No pharmacologic dilation. Retinal fundus photograph
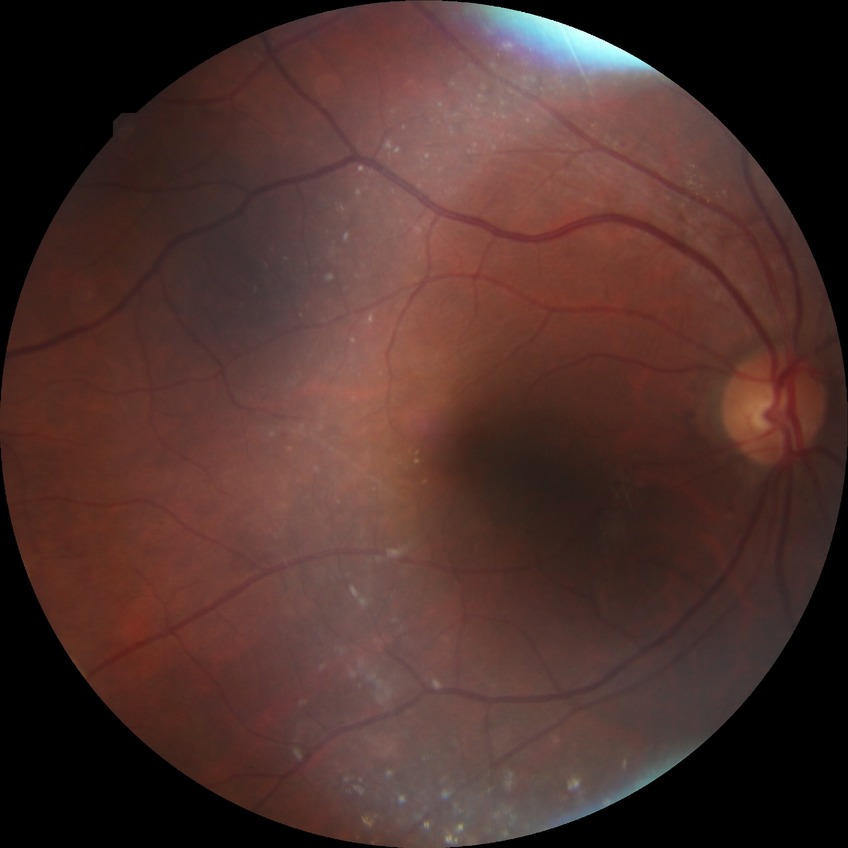 DR grade is SDR. Disease class: non-proliferative diabetic retinopathy.